Color fundus image, graded on the modified Davis scale
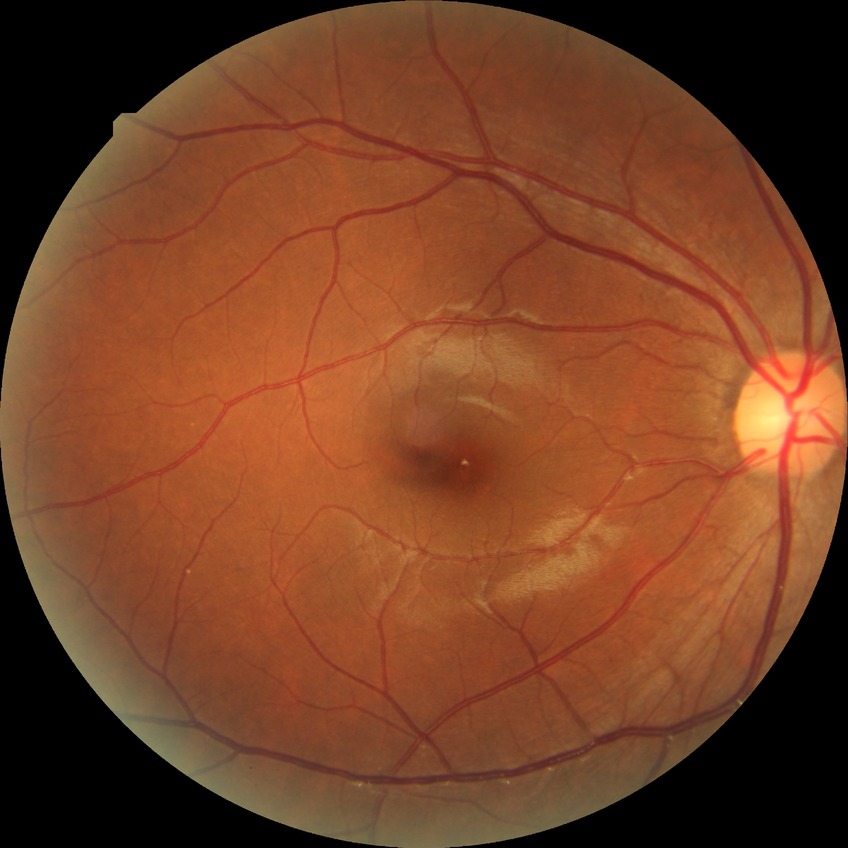

diabetic retinopathy (DR)=NDR (no diabetic retinopathy).